Fundus photo, modified Davis classification: 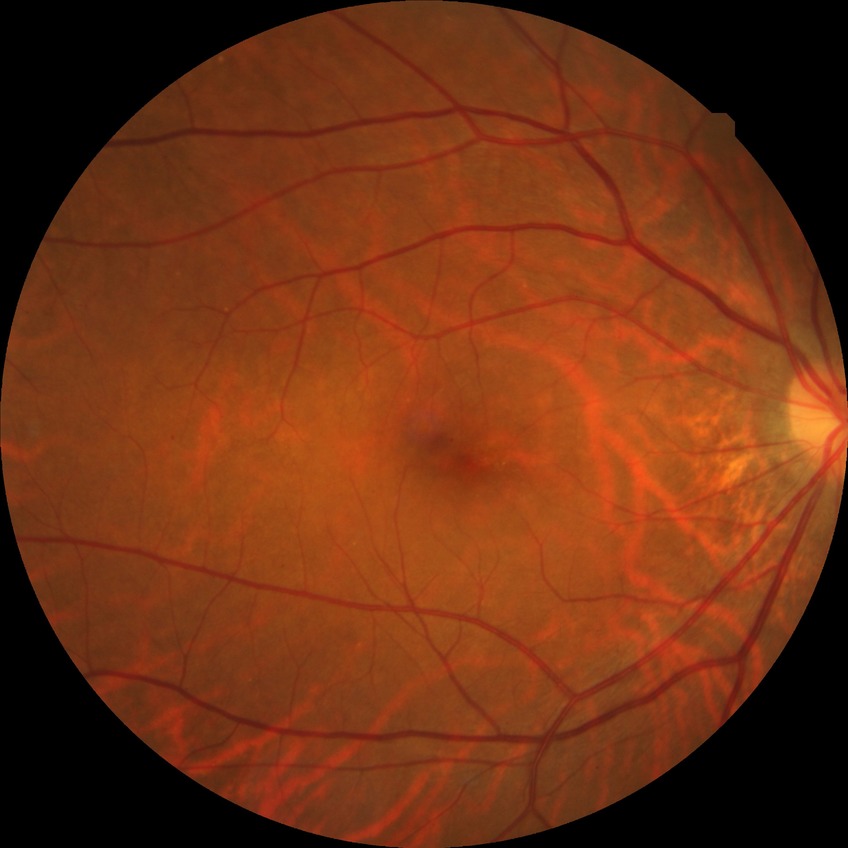

Davis grading: simple diabetic retinopathy.